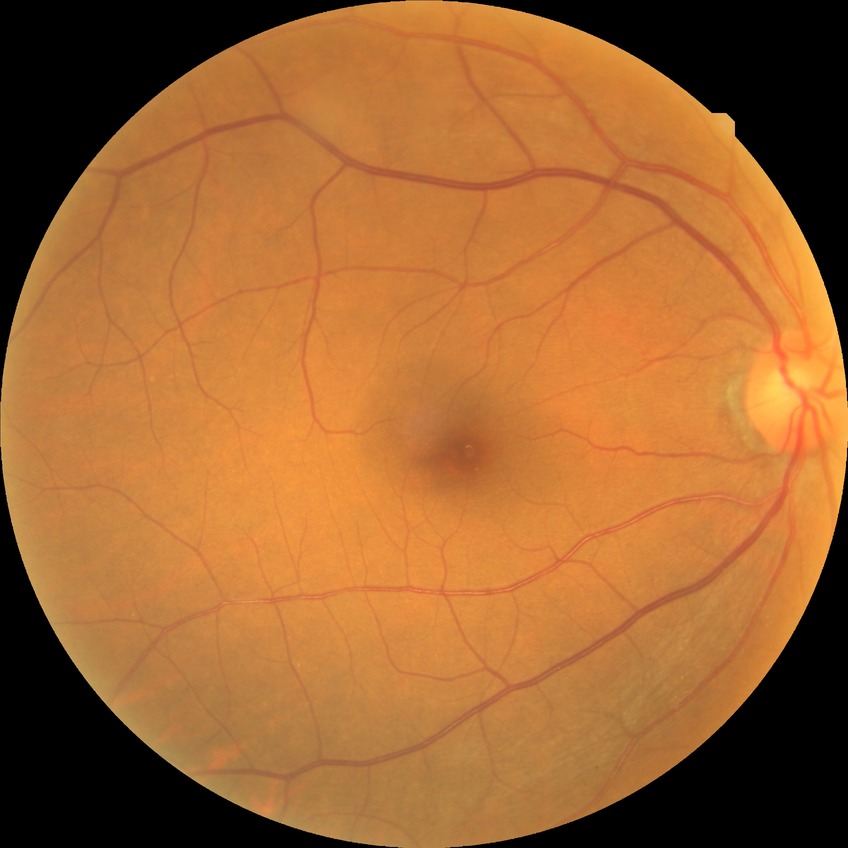
Diabetic retinopathy (DR) is no diabetic retinopathy (NDR).